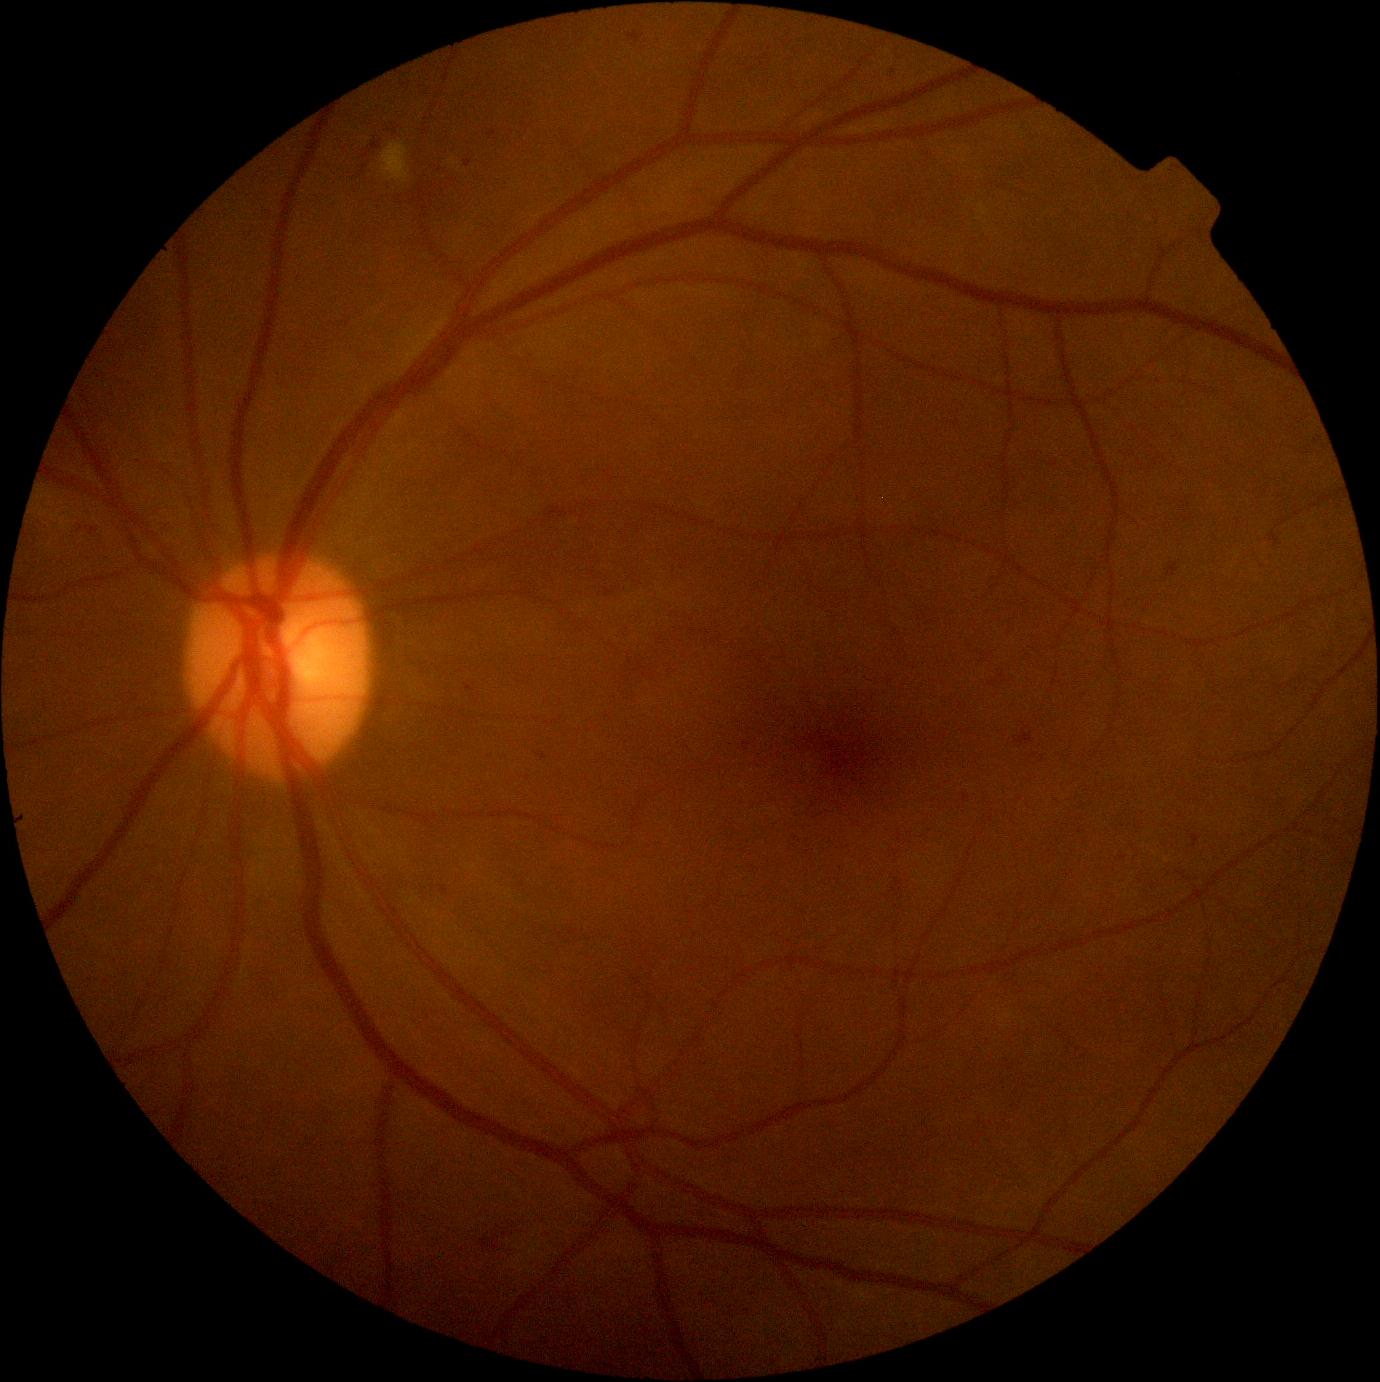

Disease class: non-proliferative diabetic retinopathy.
DR stage is grade 2 (moderate NPDR).